Undilated pupil. 30° FOV — 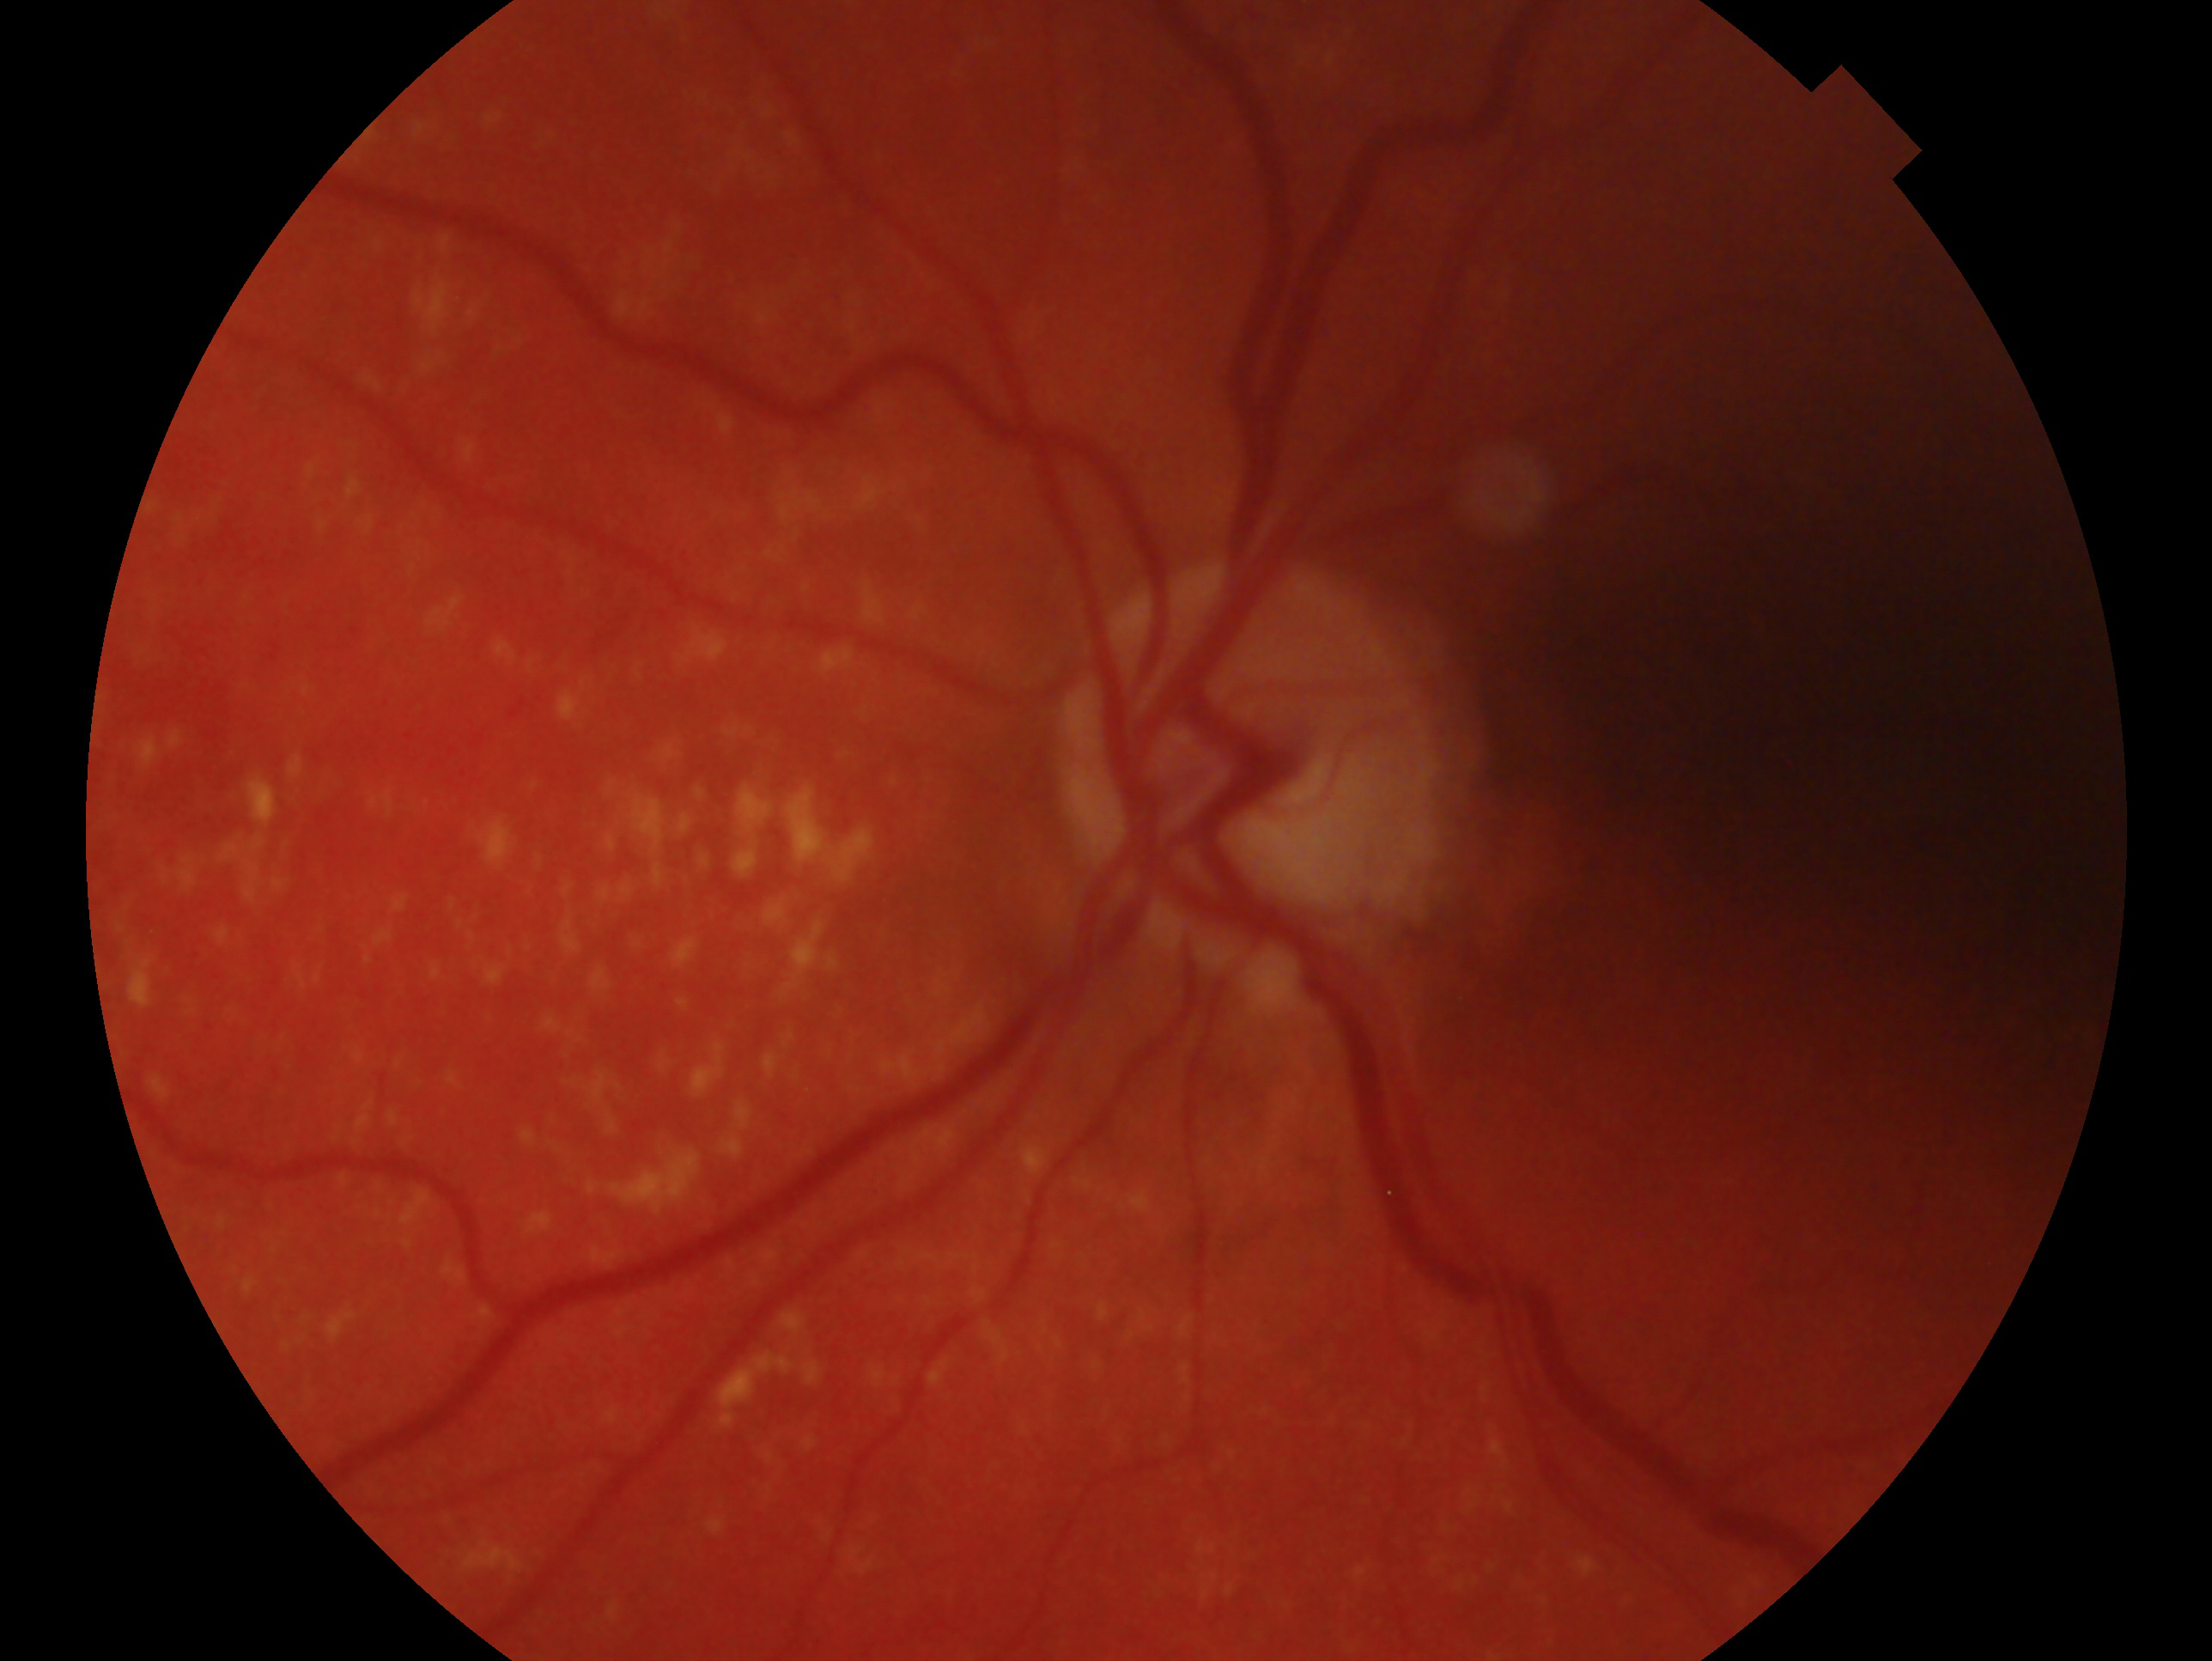 {
  "eye": "left",
  "glaucoma_dx": "glaucomatous"
}